Modified Davis classification:
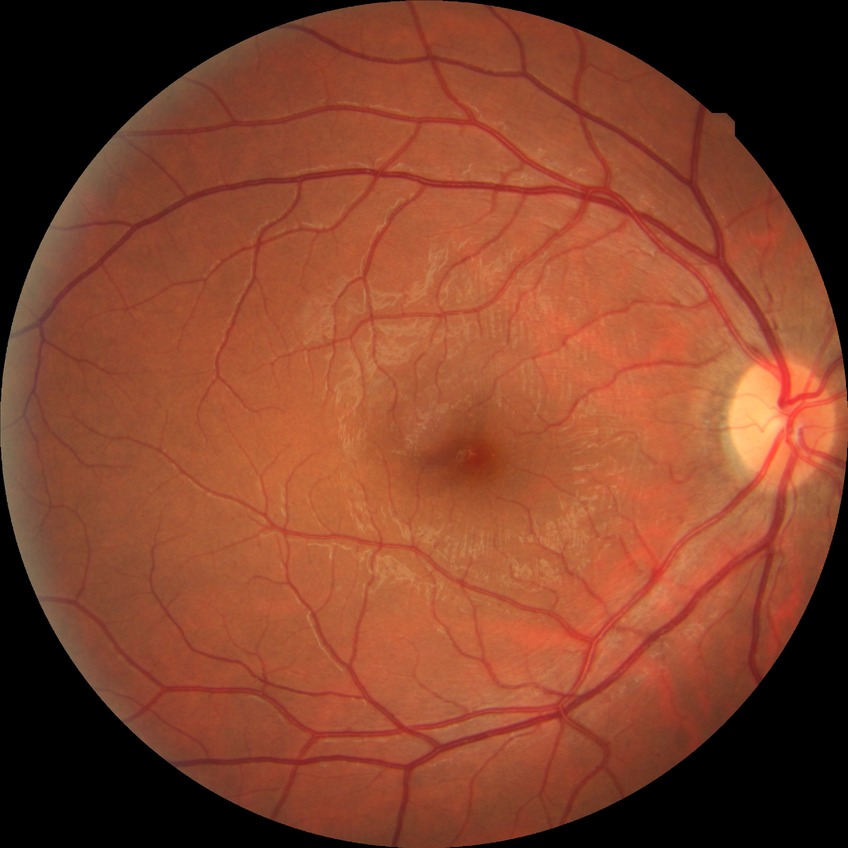
davis_grade: no diabetic retinopathy (NDR)